Color fundus photograph; image size 2048x1536; 45° field of view — 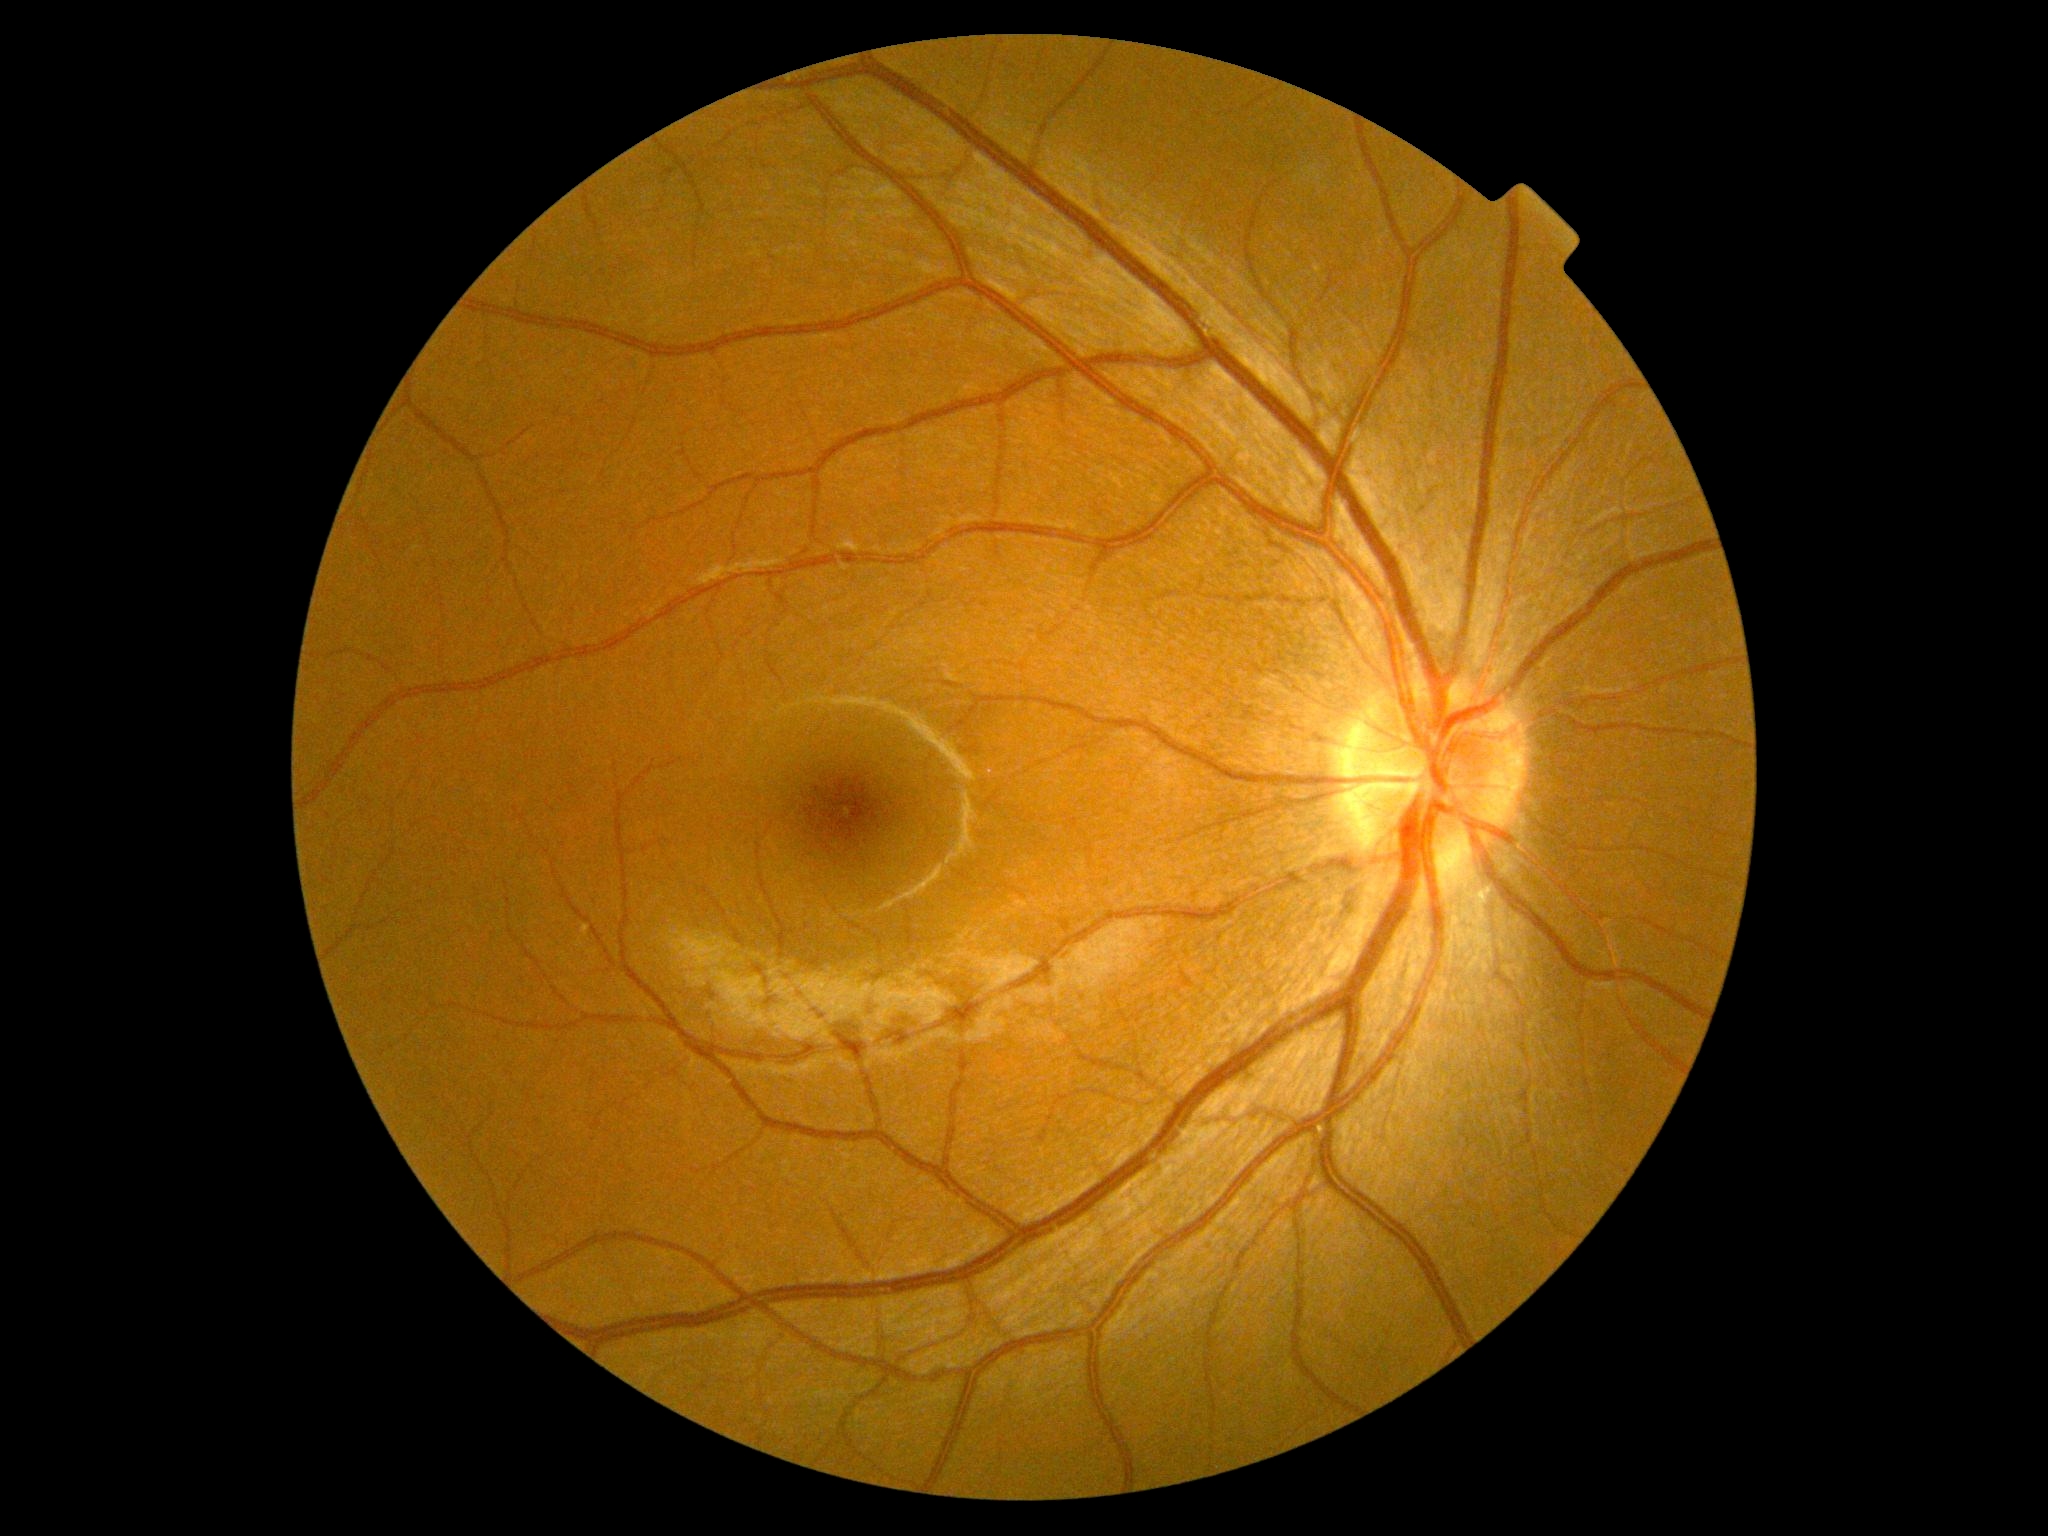 No diabetic retinal disease findings. DR severity: no apparent diabetic retinopathy (grade 0).